2352x1568; 45° FOV; color fundus image:
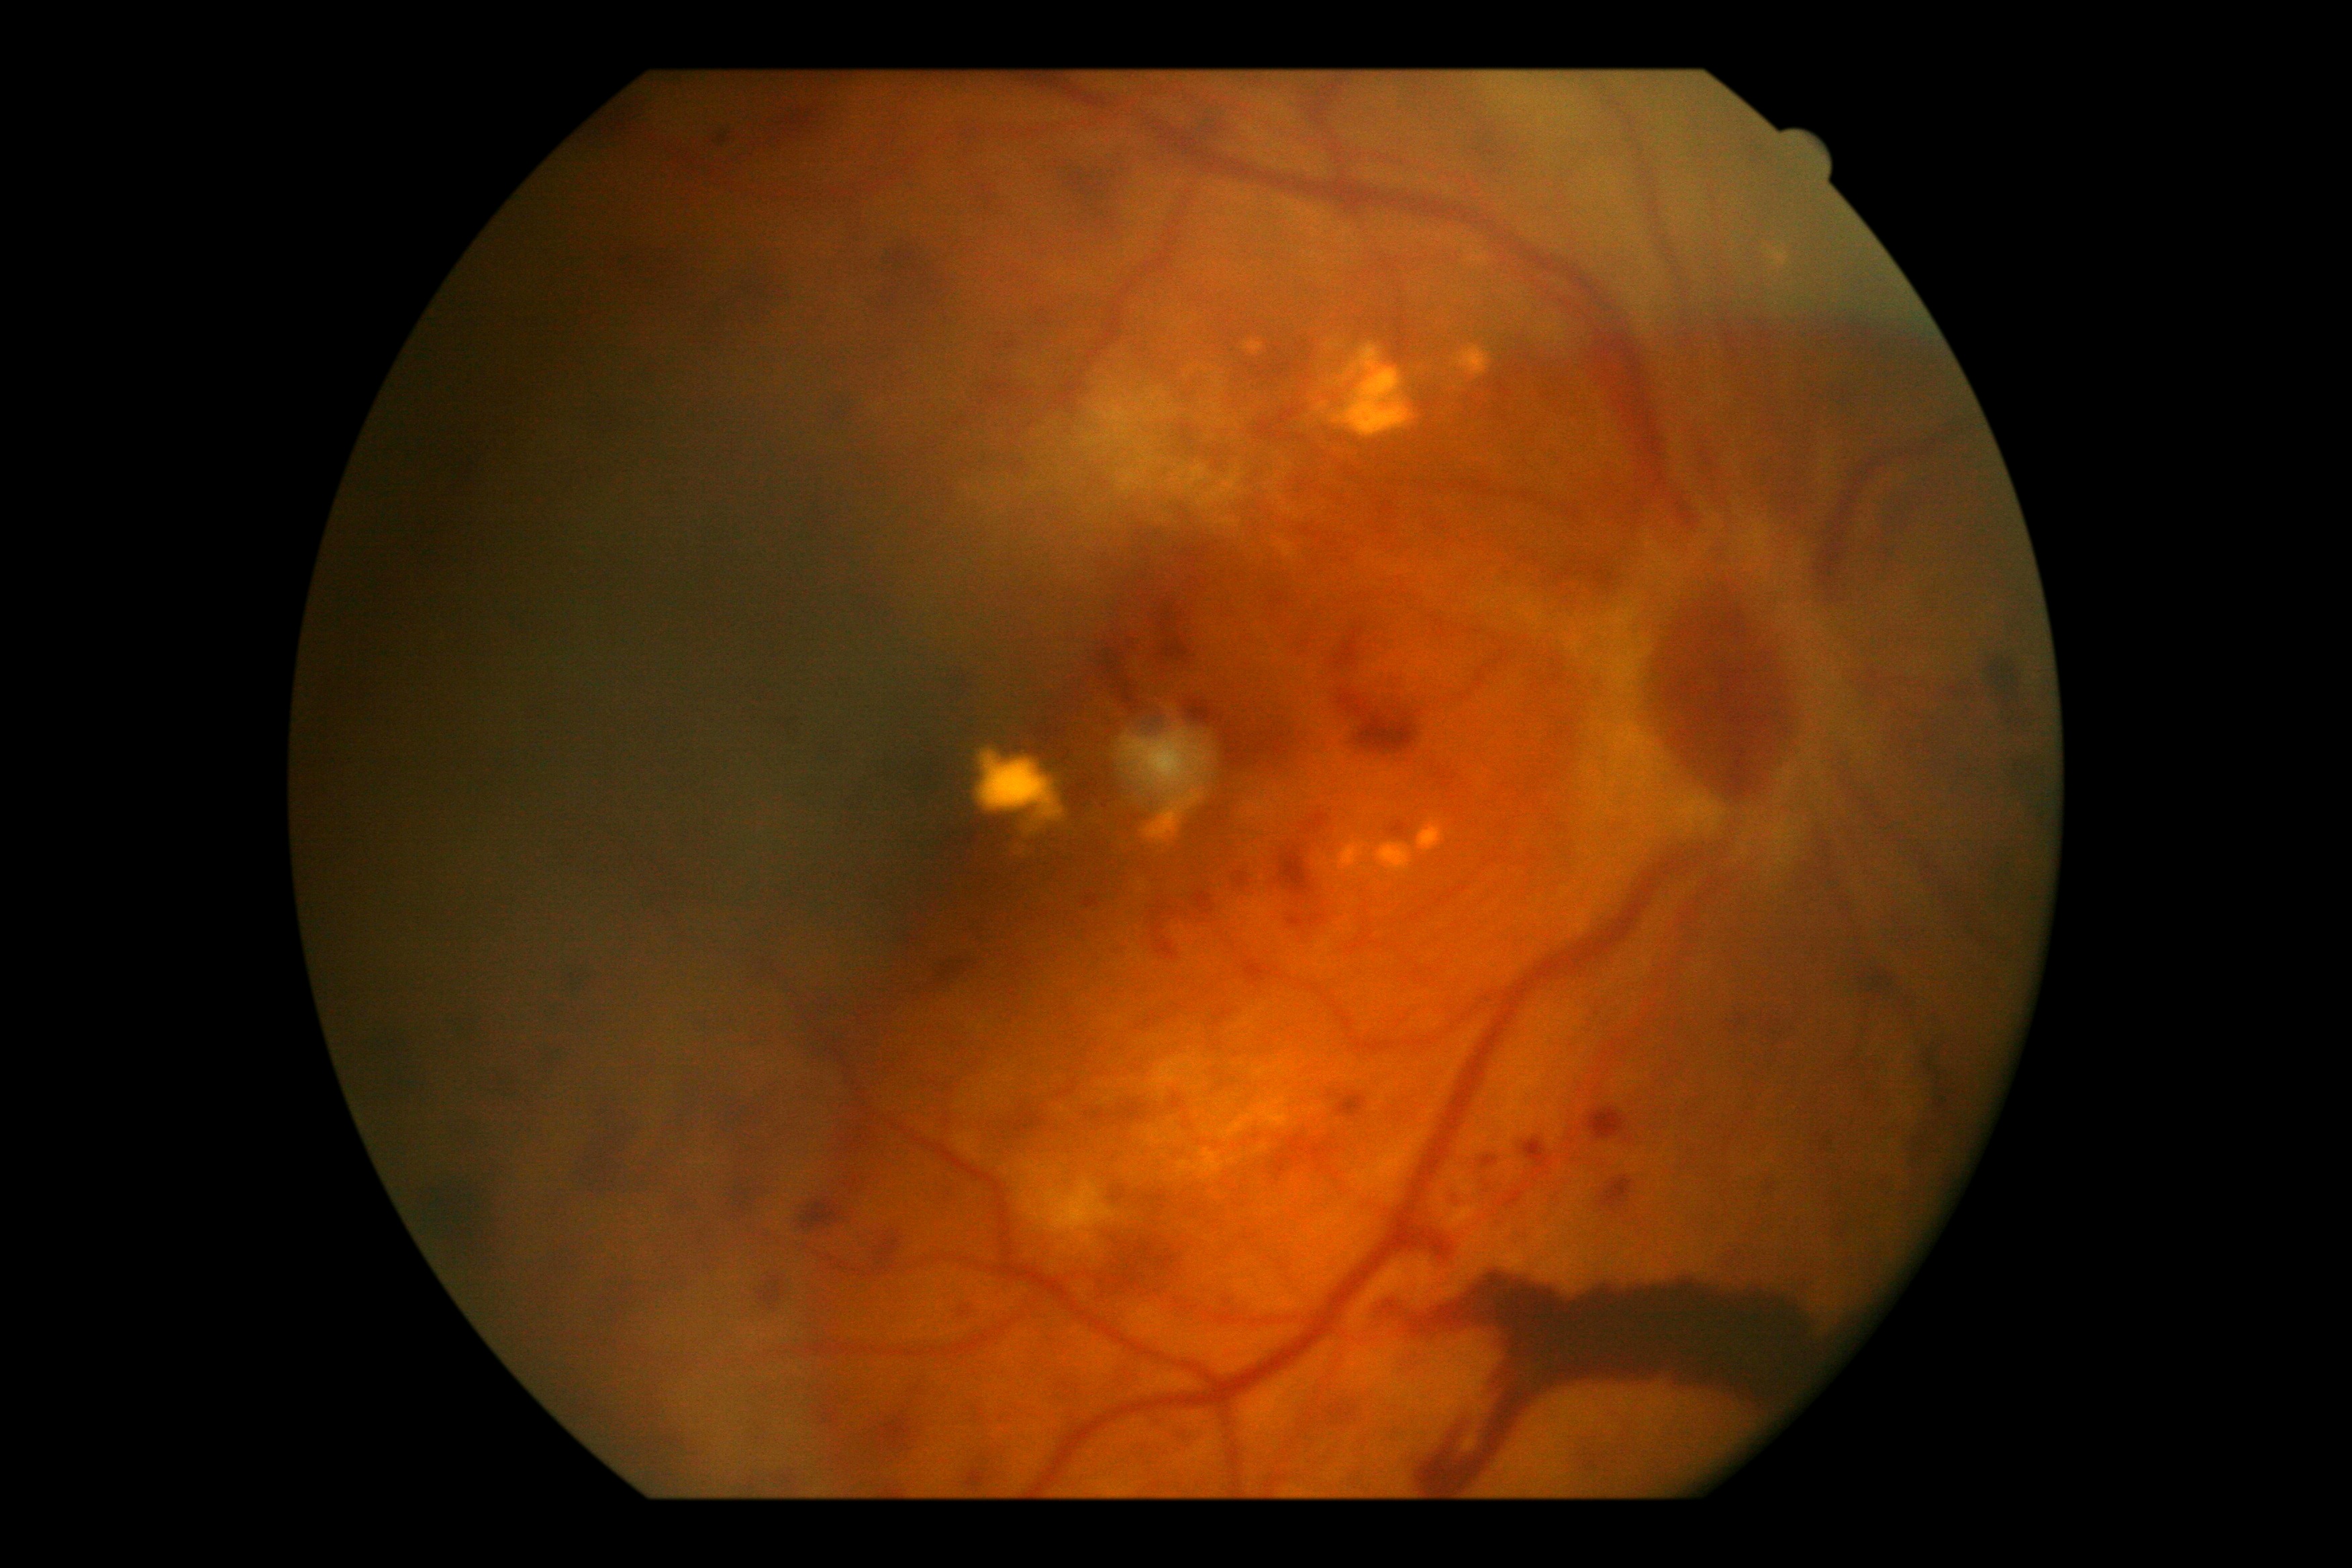
Diabetic retinopathy grade is 4 — neovascularization and/or vitreous/pre-retinal hemorrhage.
Disease class: proliferative diabetic retinopathy.